FOV: 50 degrees.
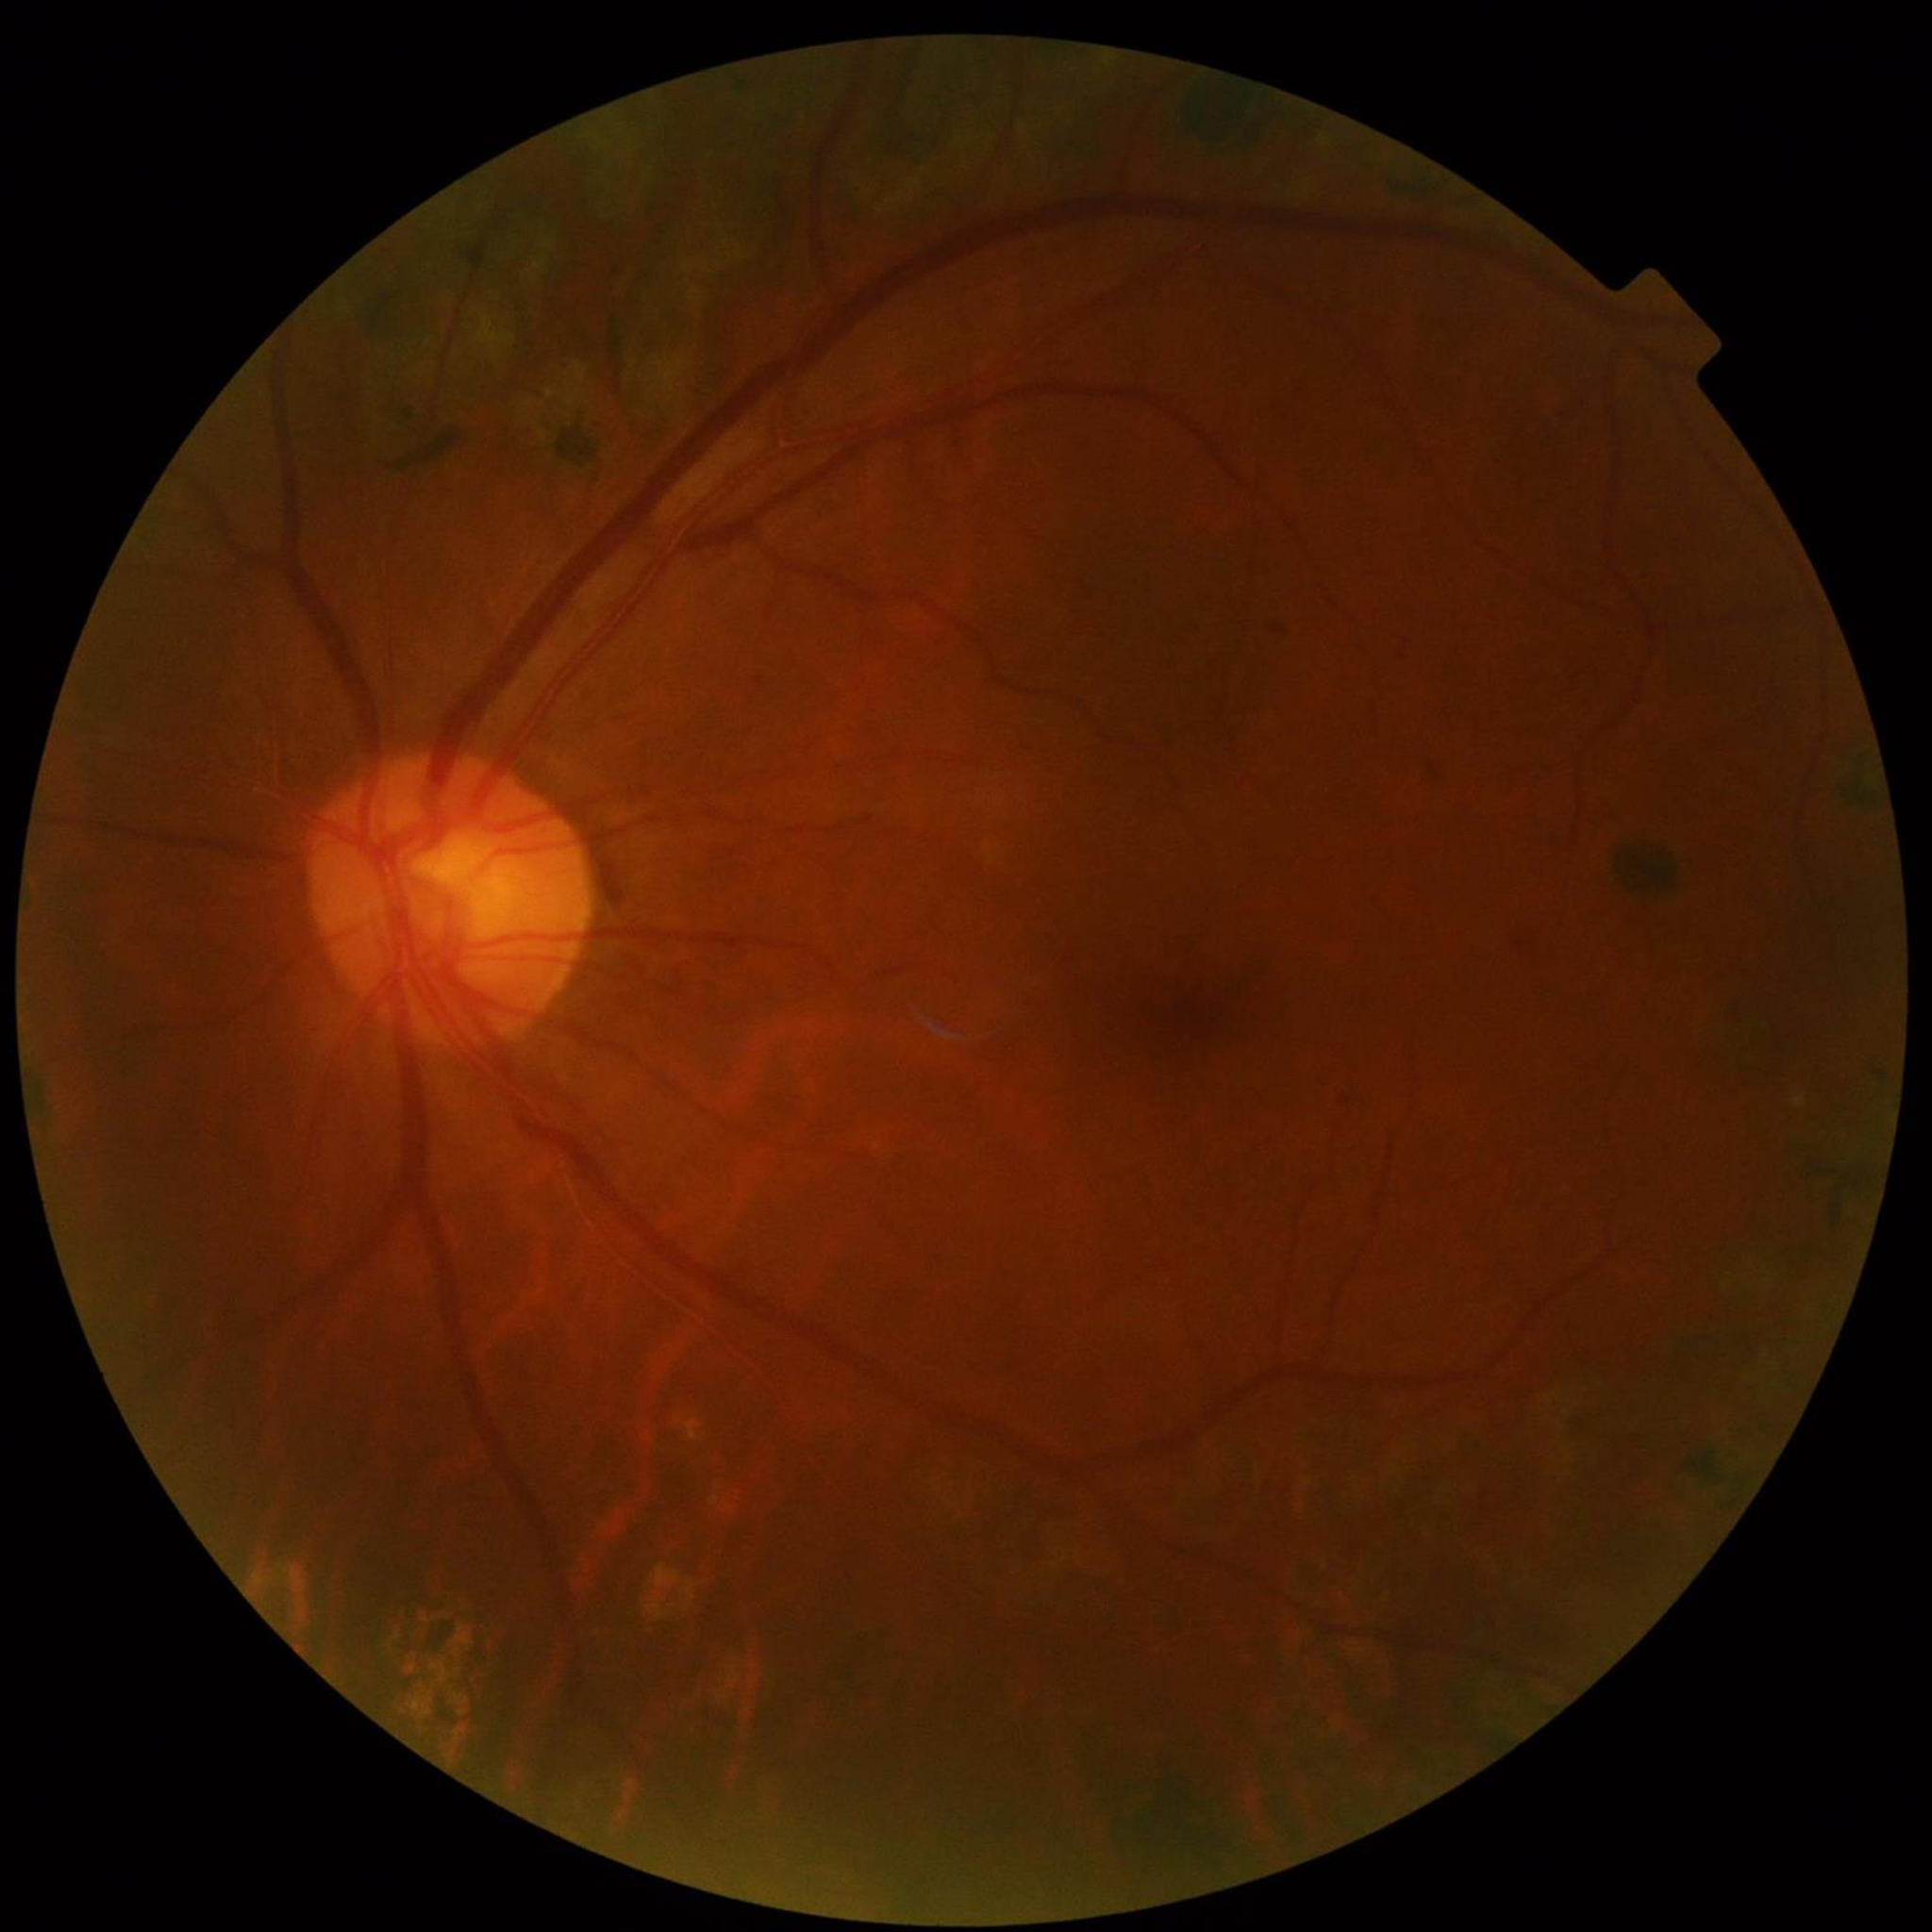

Disease class: DR | Quality: no concerns identified.